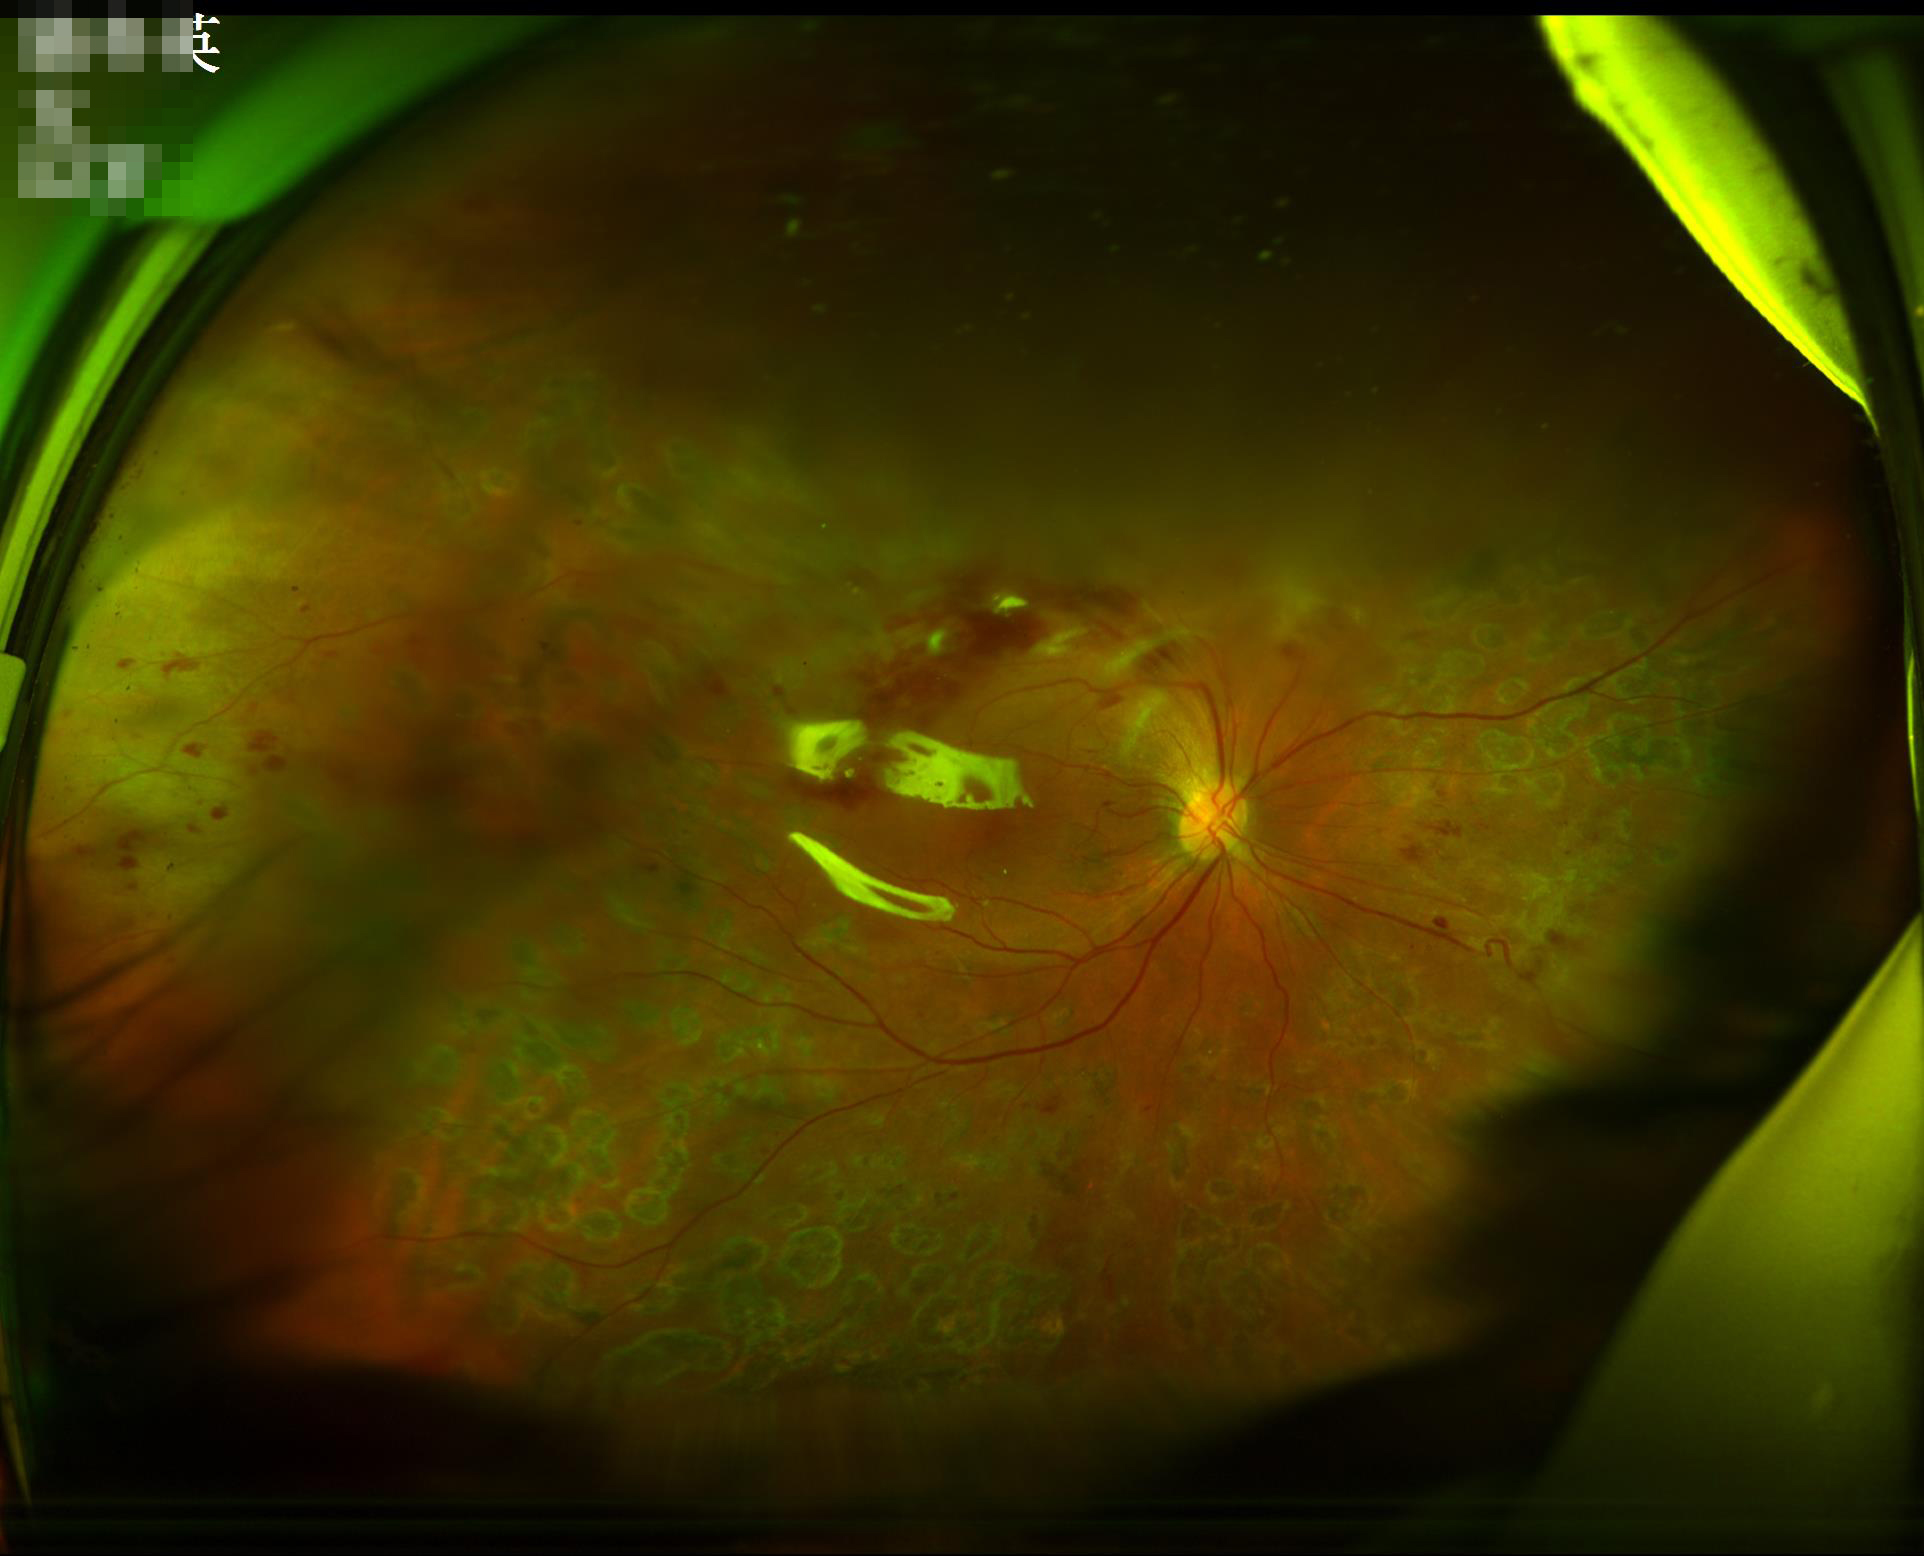

Vessels and details are readily distinguishable.
Overall quality is poor; the image is difficult to grade.
There is over- or under-exposure or a color cast.
No noticeable blur.